2212x1659 · color fundus photograph · 45° field of view.
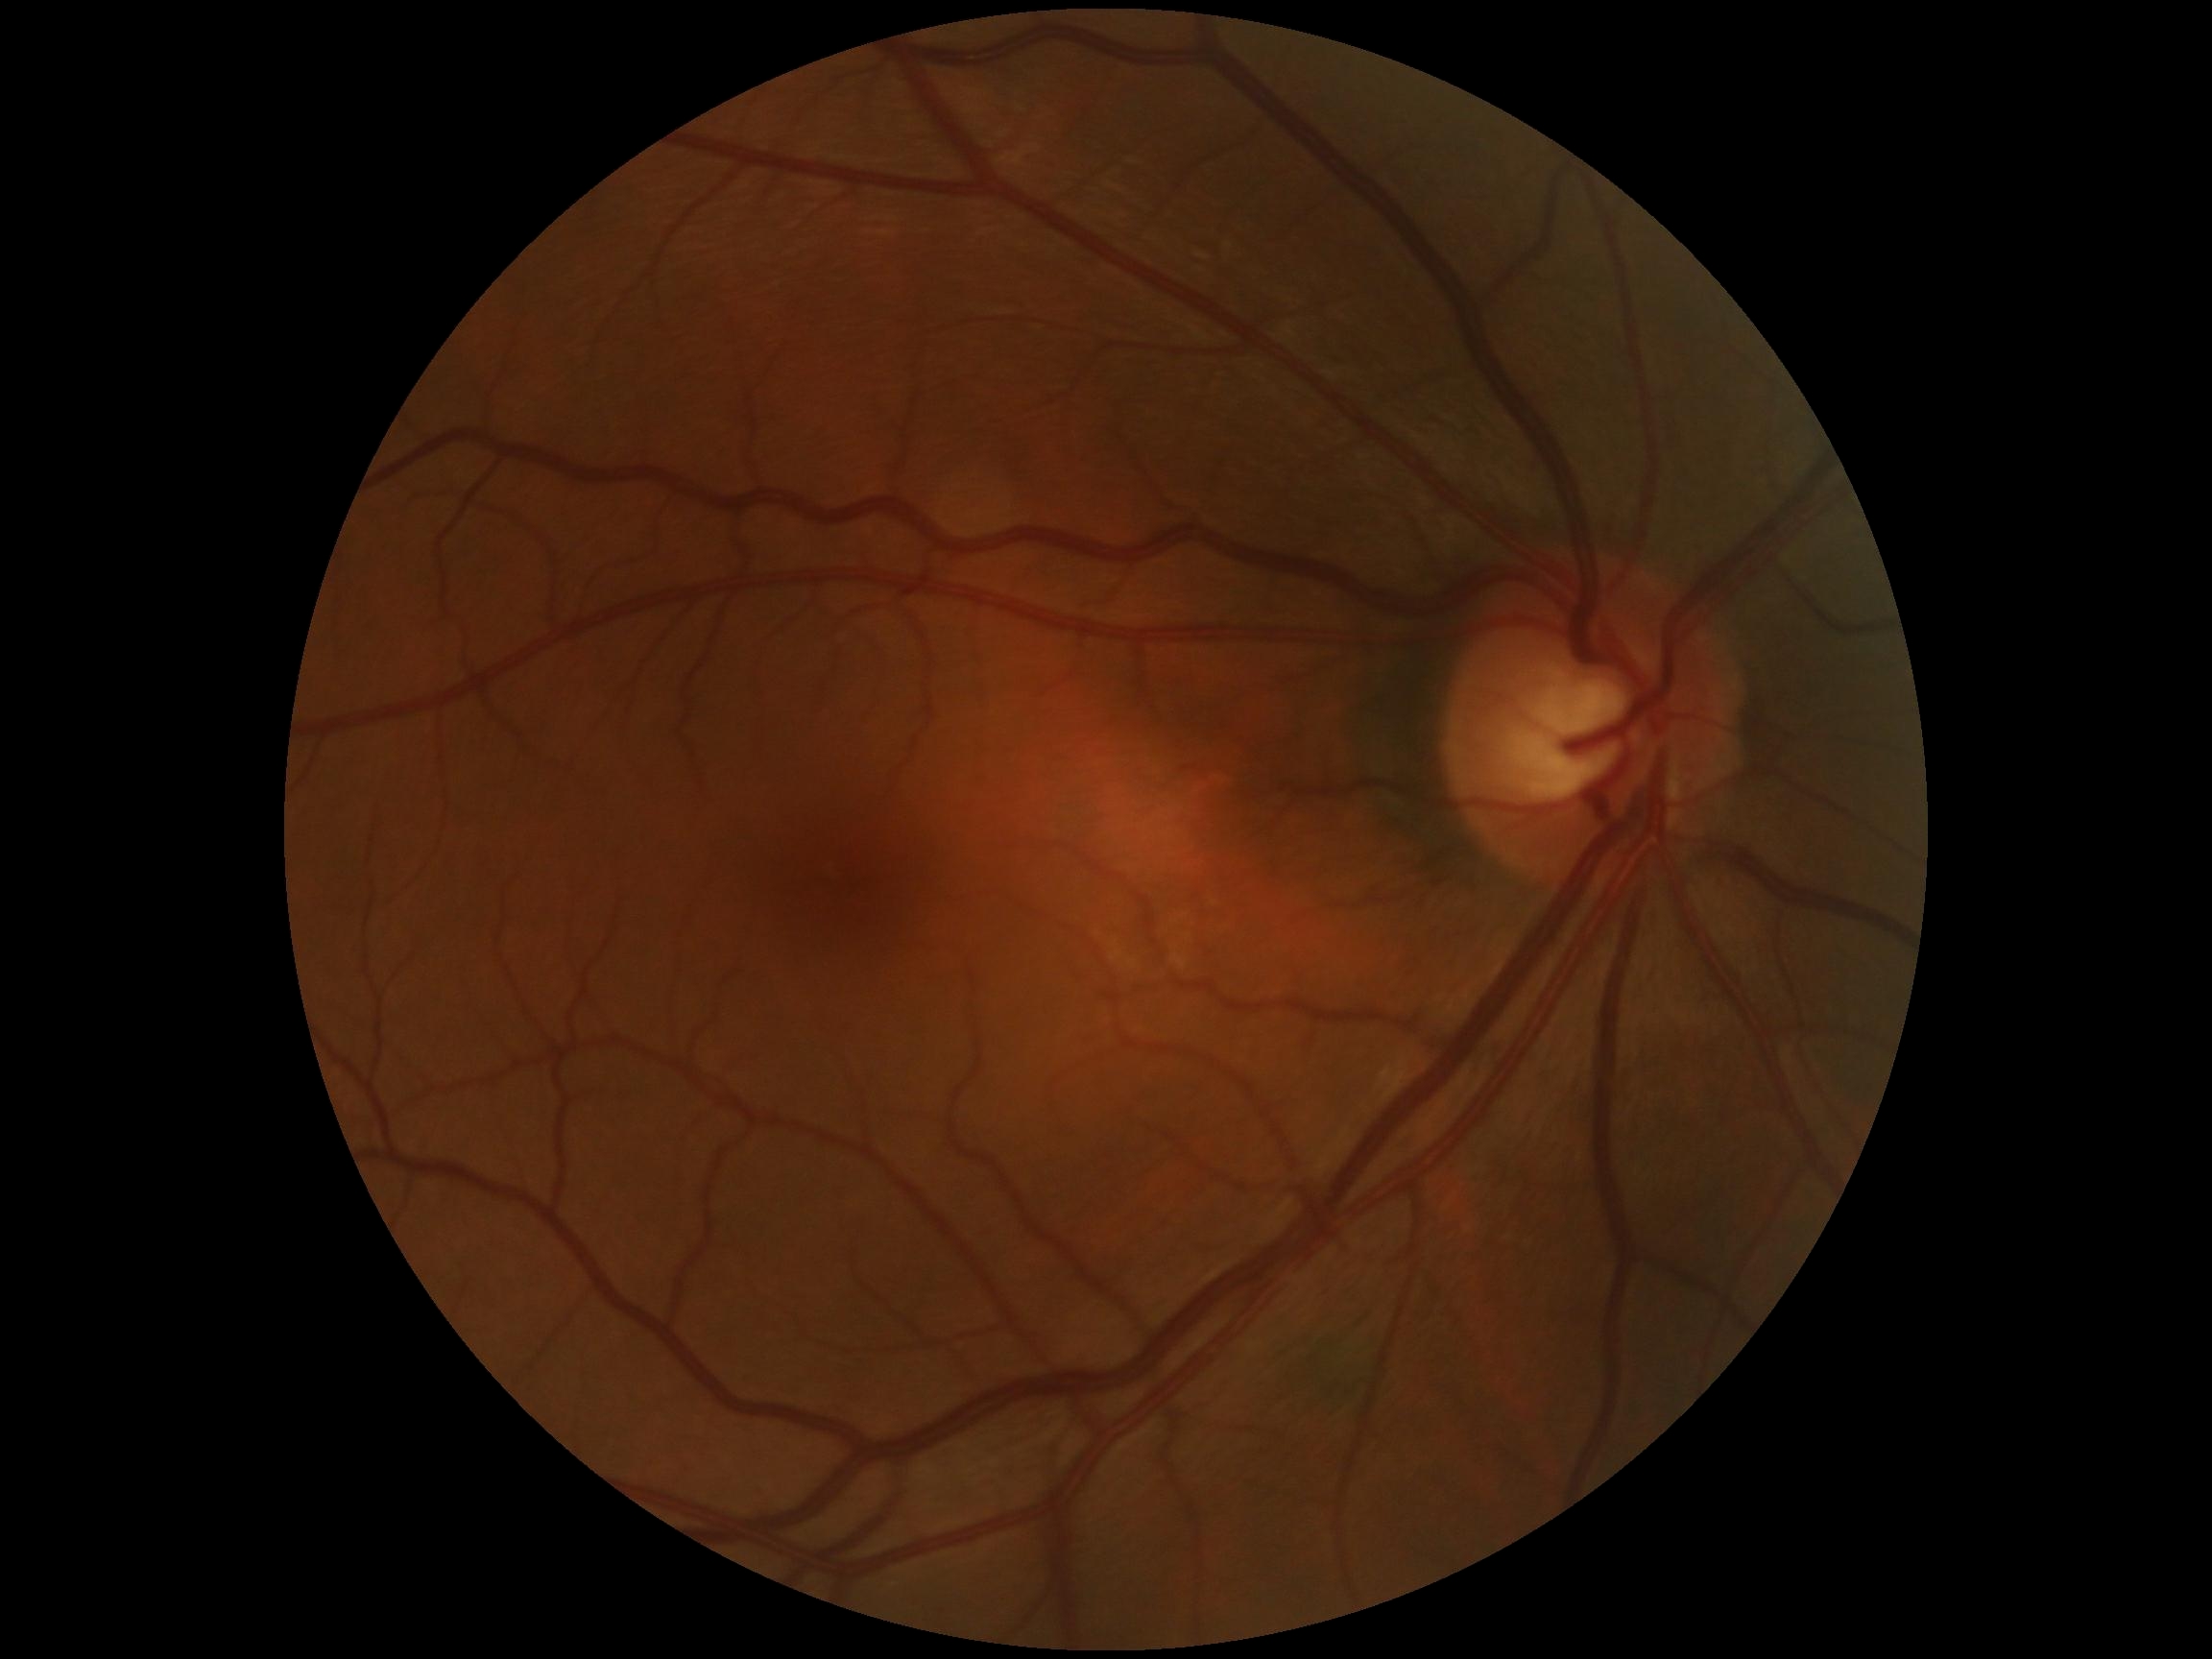
diabetic retinopathy severity = grade 0.